Wide-field contact fundus photograph of an infant. 1440x1080px.
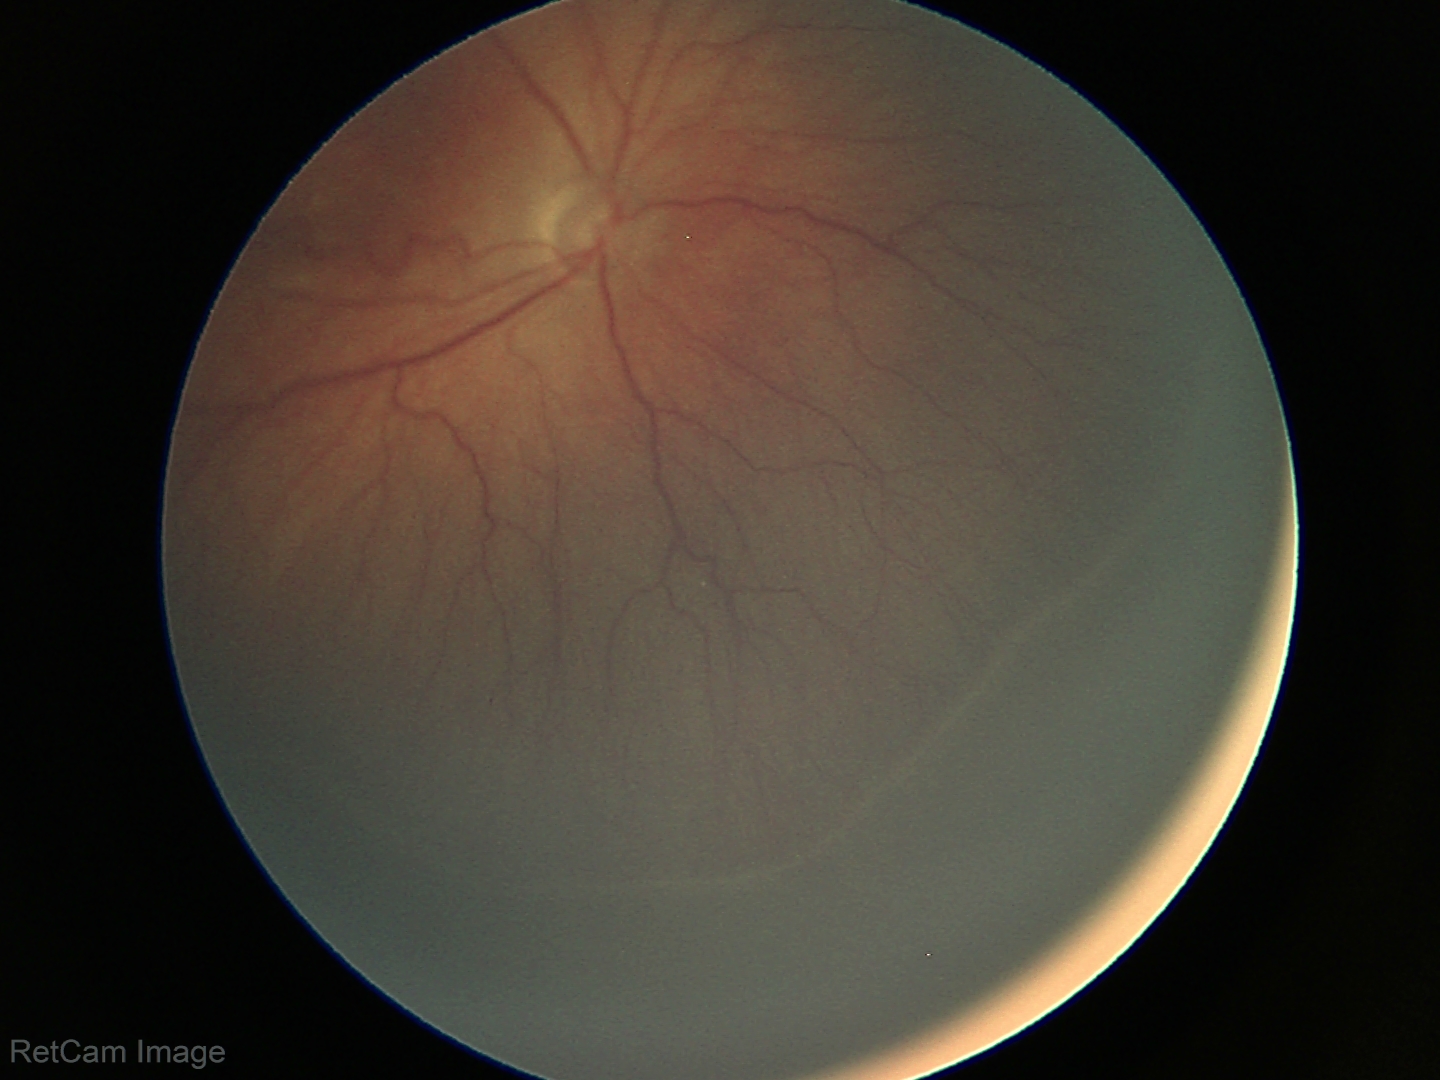

Q: What is the plus-form classification?
A: no plus disease
Q: What was the screening finding?
A: ROP stage 3 — ridge with extraretinal fibrovascular proliferation